FOV: 45 degrees:
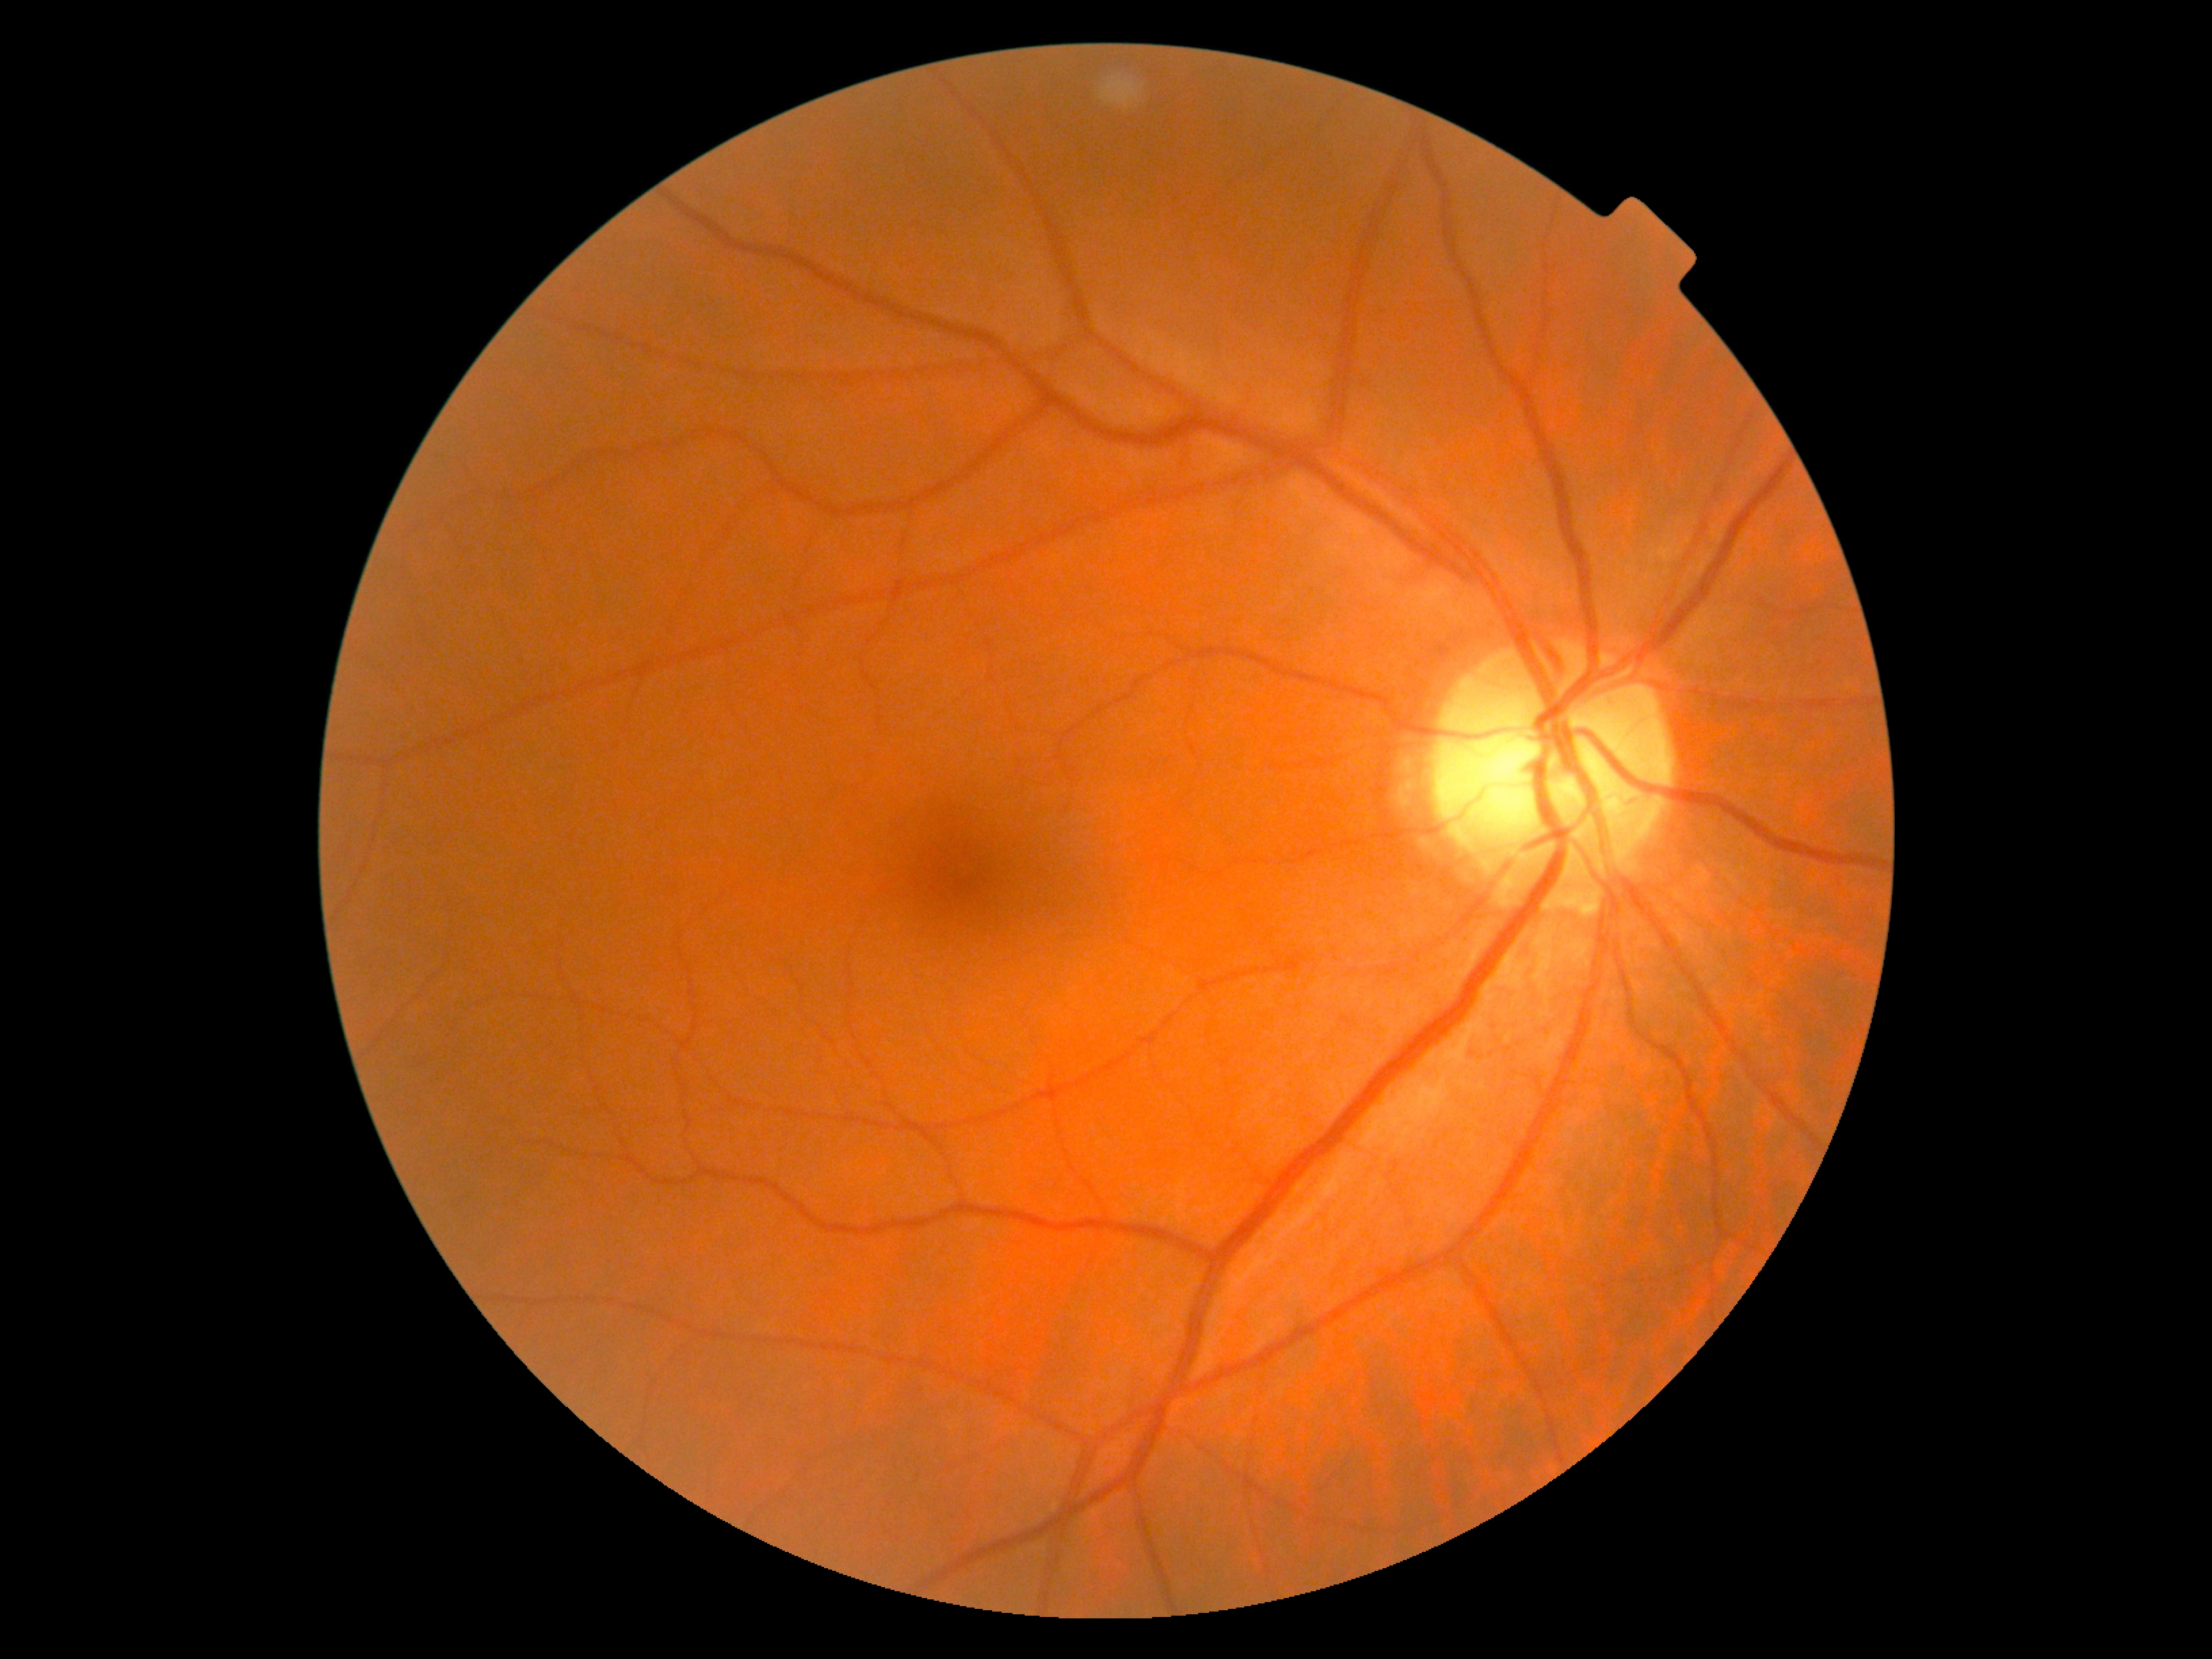 DR is no apparent retinopathy (grade 0) — no visible signs of diabetic retinopathy.